Captured with the Phoenix ICON (100° field of view); 1240 x 1240 pixels; infant wide-field fundus photograph: 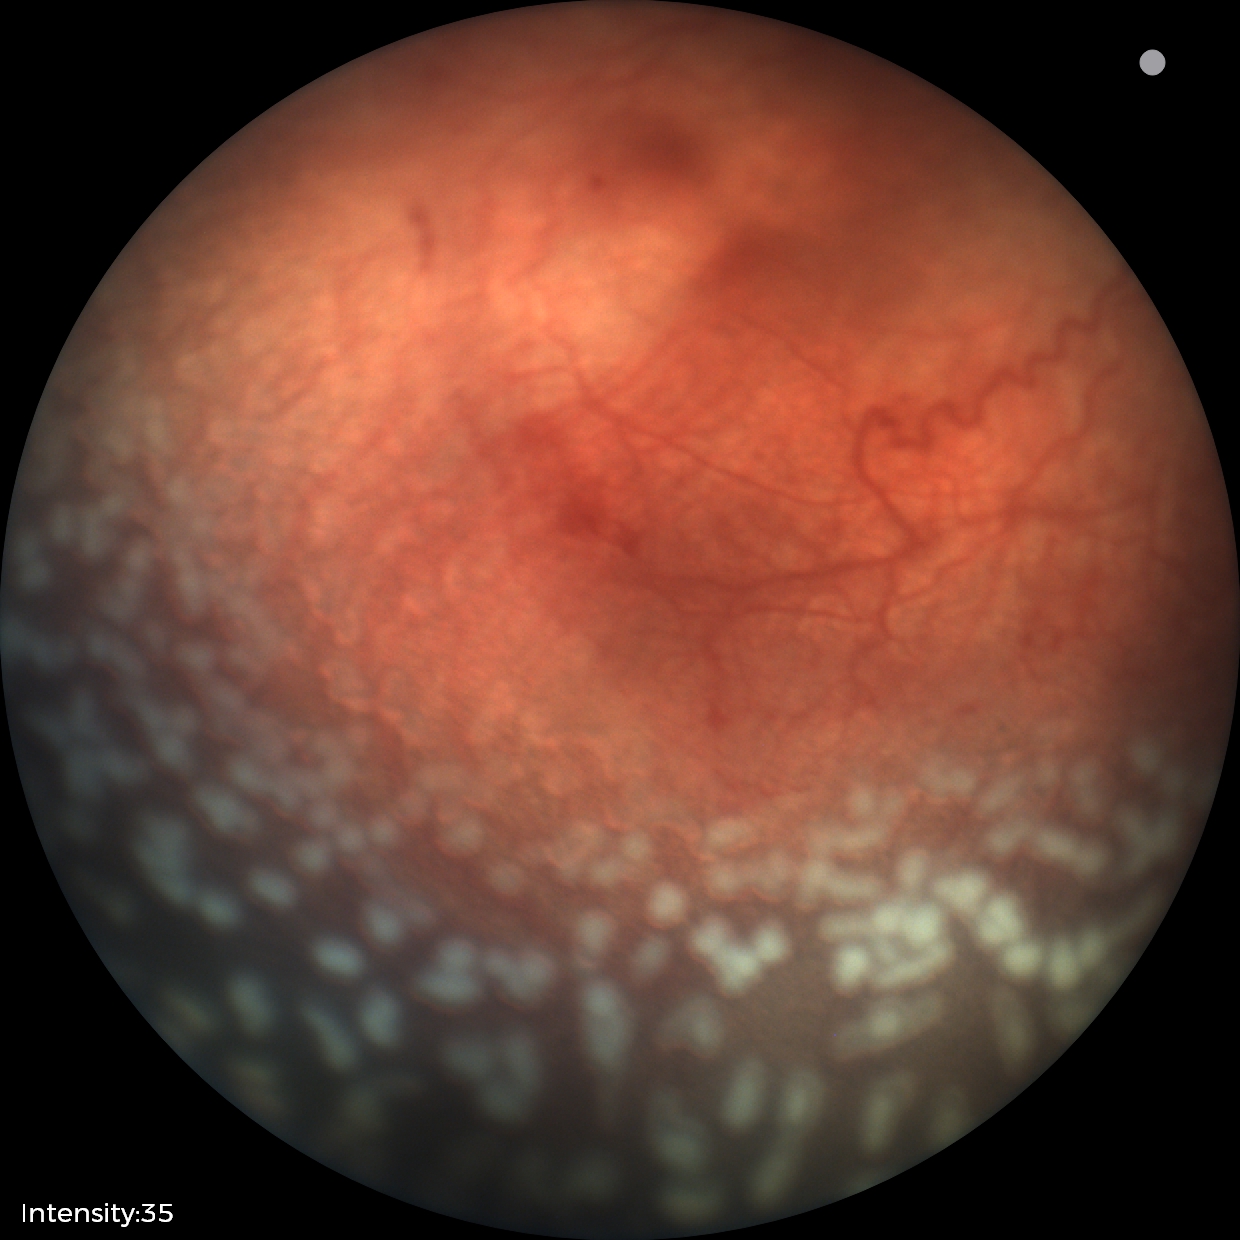 Screening series with ROP stage 2 — ridge with height and width at the demarcation line. Plus disease was diagnosed.